Color fundus photograph.
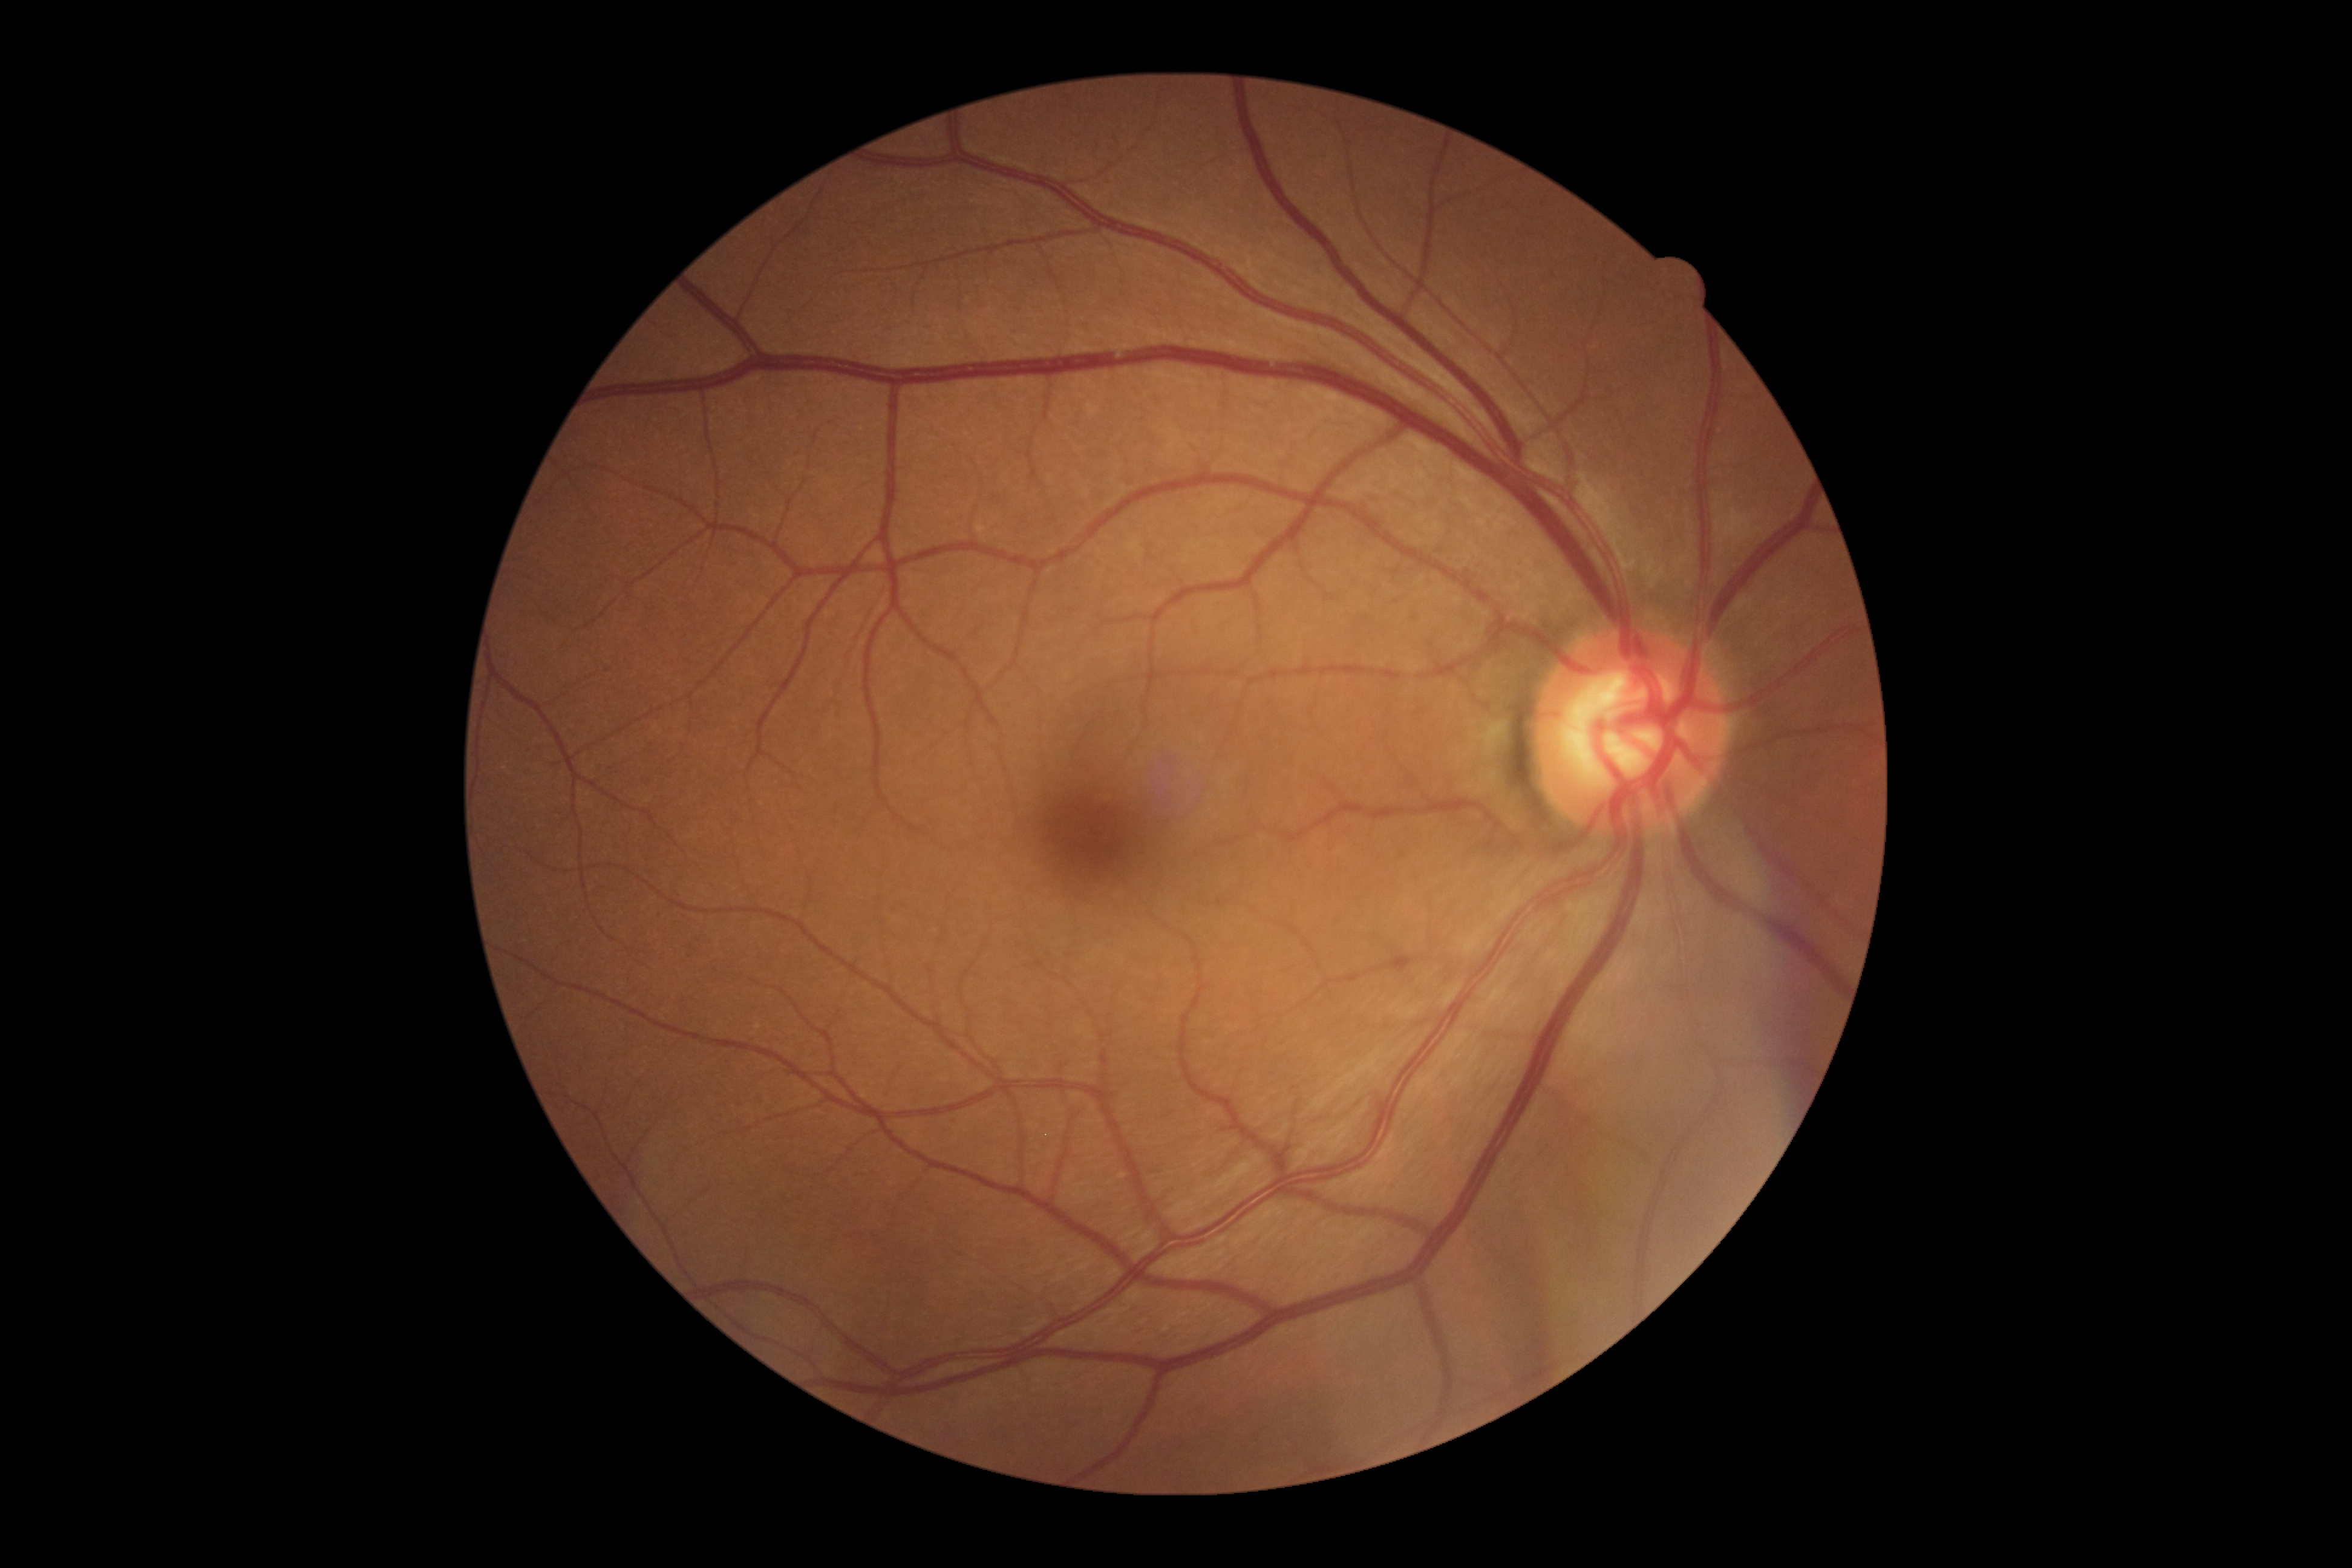

DR stage = 0/4.